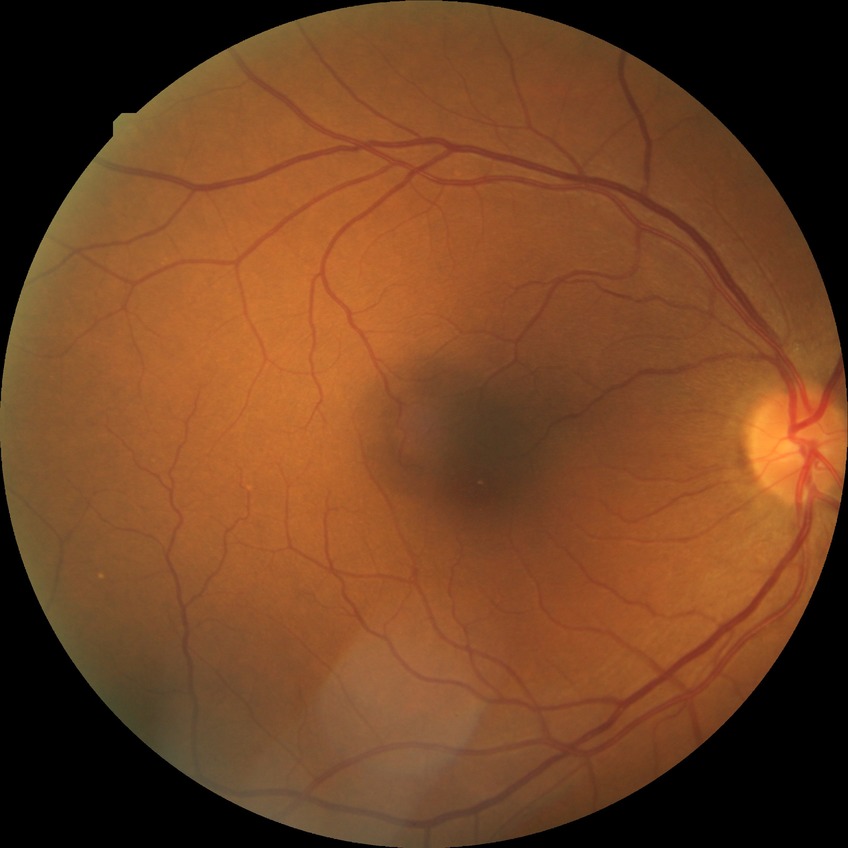 Assessment:
- diabetic retinopathy (DR) — NDR (no diabetic retinopathy)